Retinal fundus photograph.
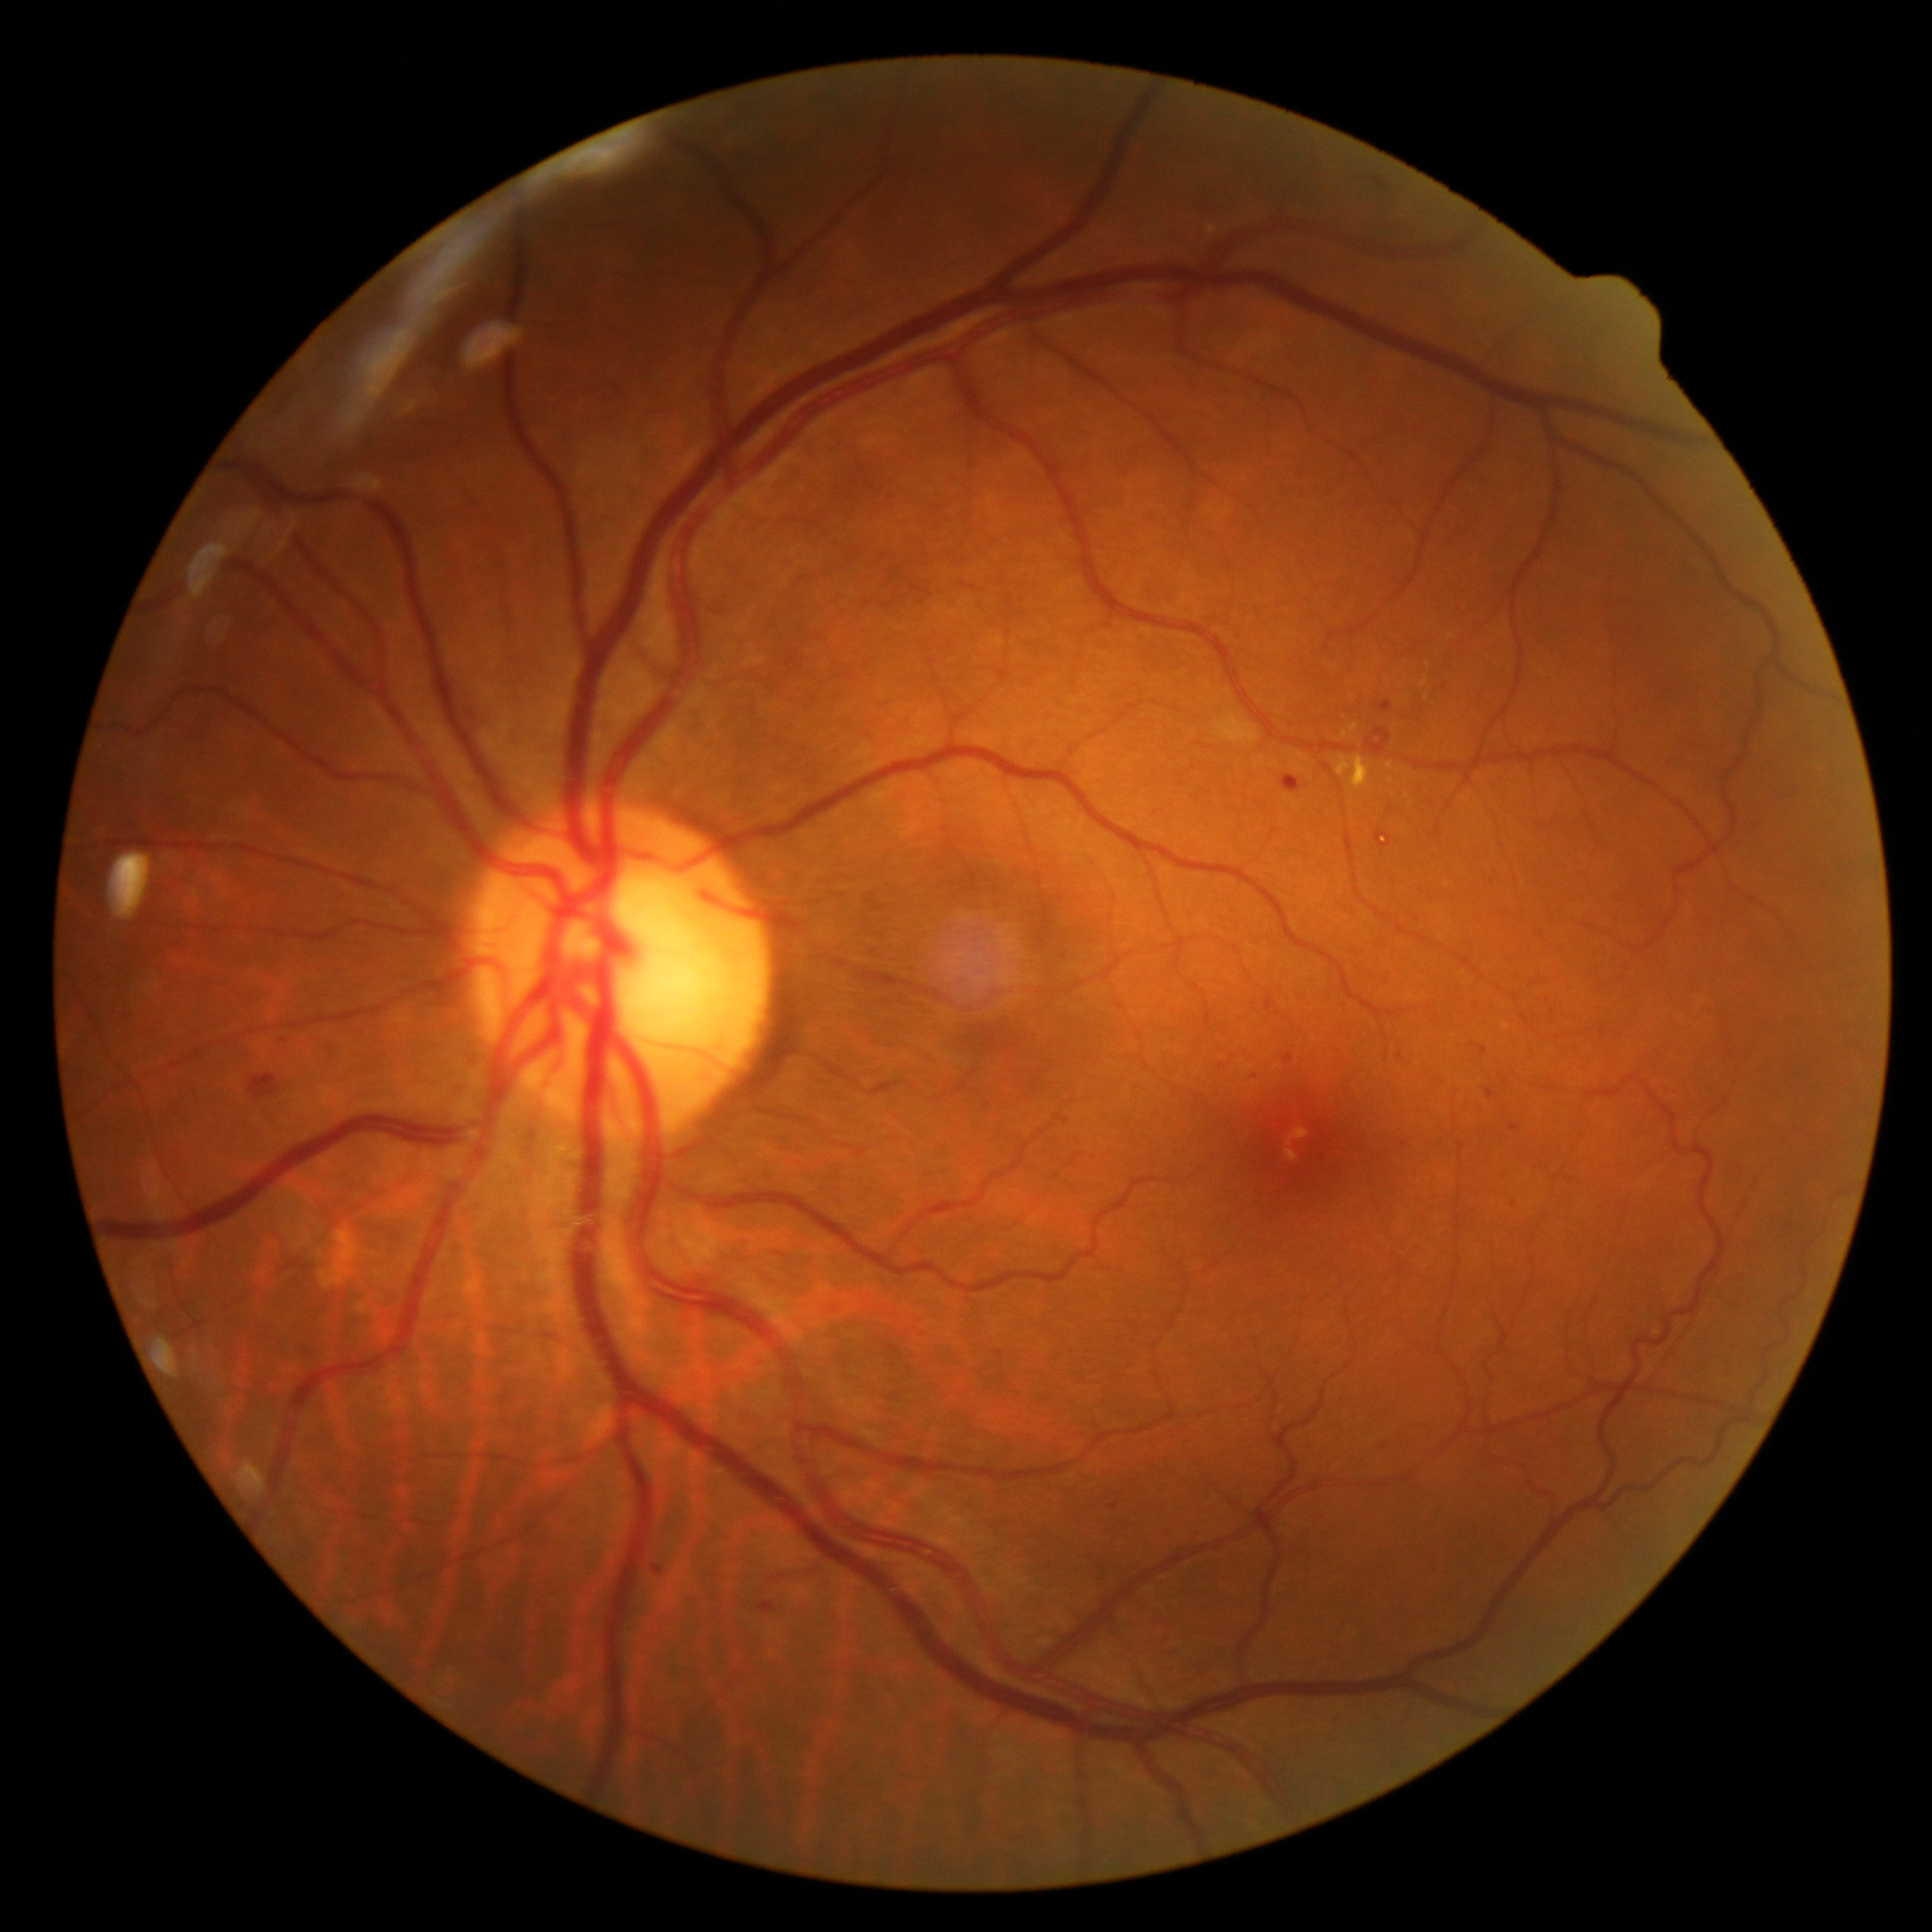 Diabetic retinopathy is grade 2 (moderate NPDR). Hemorrhages present at 1366 727 1391 756; 249 1074 279 1100; 1265 991 1276 1011. Hard exudates include those at 1336 756 1371 792; 1422 677 1429 688; 1386 762 1394 771; 1350 724 1359 733. Small hard exudates approximately at {"x": 1429, "y": 666}; {"x": 1392, "y": 780}; {"x": 1345, "y": 734}; {"x": 1451, "y": 636}. No soft exudates identified. Microaneurysms present at 1486 1088 1495 1100; 651 1565 661 1576; 757 1603 776 1613; 1283 1054 1294 1064; 1379 700 1394 713; 1375 831 1391 849; 1480 1045 1489 1056; 1510 1126 1521 1132; 1282 775 1302 794. Small microaneurysms approximately at {"x": 284, "y": 1041}; {"x": 1405, "y": 1145}; {"x": 1477, "y": 1007}; {"x": 1255, "y": 1076}; {"x": 1385, "y": 1447}.